2352 x 1568 pixels; 45° field of view: 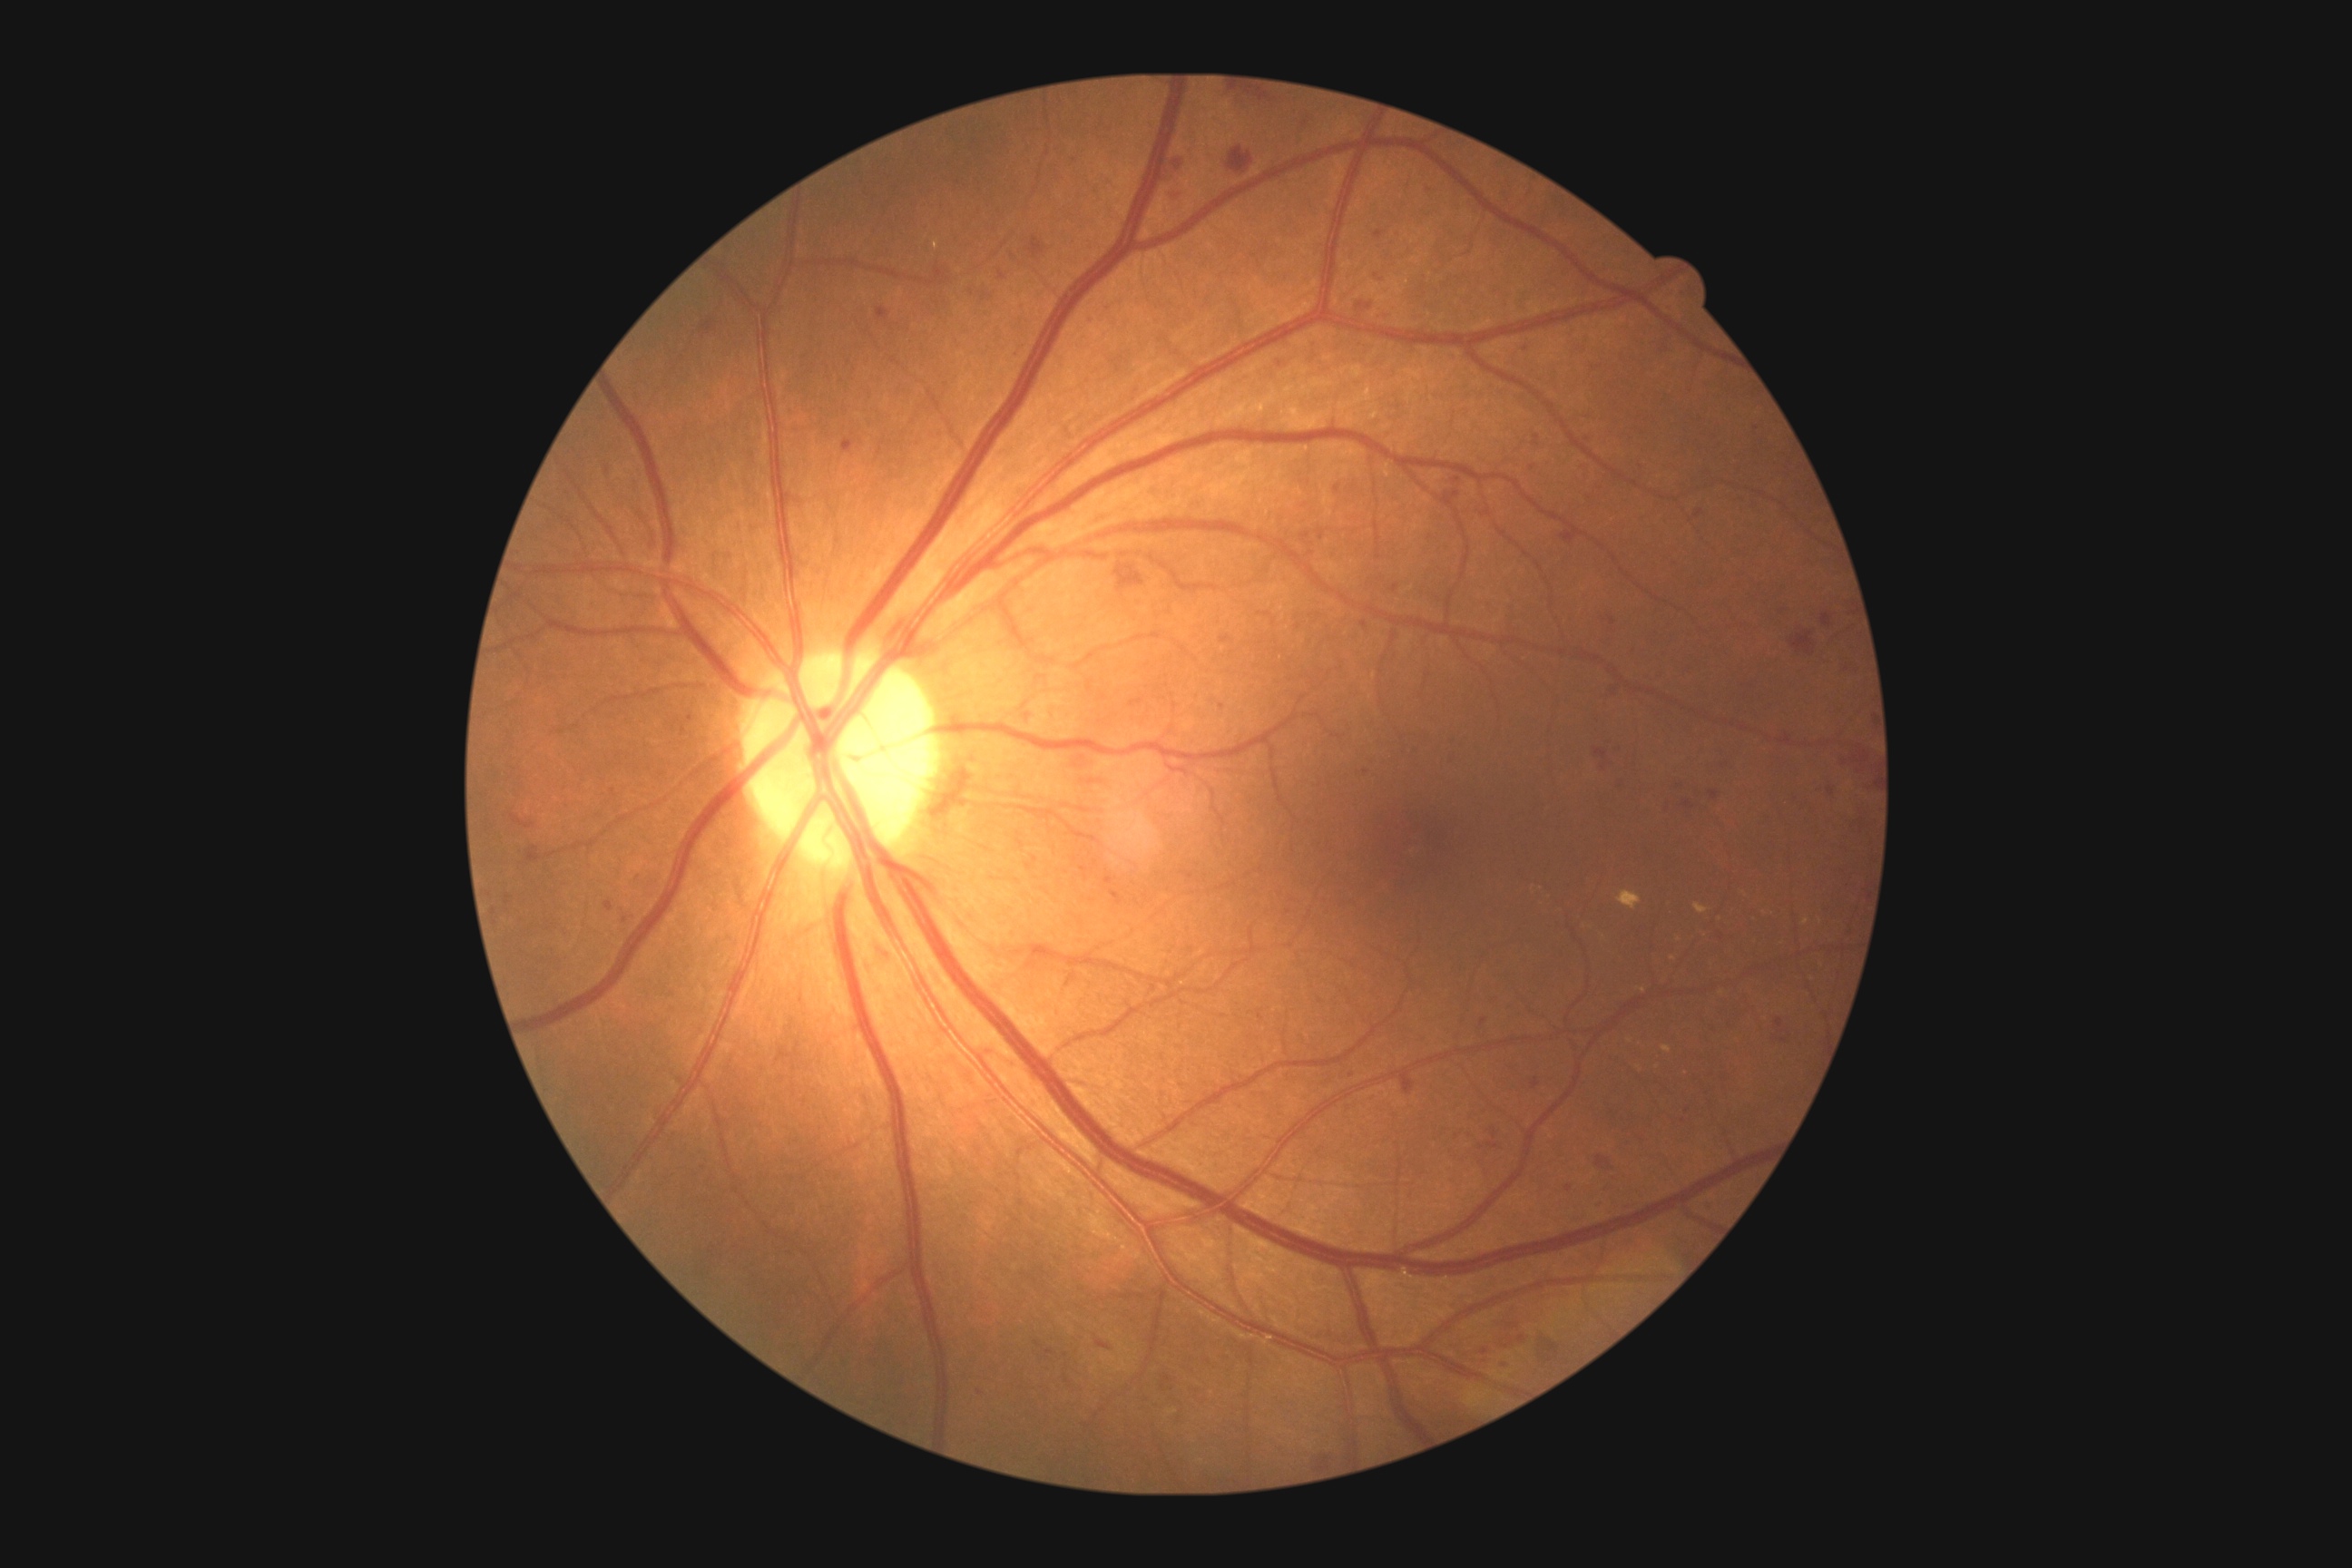

{"partial": true, "dr_grade": 2, "lesions": {"he": [[665, 1004, 678, 1015], [1046, 1349, 1055, 1355], [1028, 237, 1044, 259], [926, 266, 950, 286], [1444, 750, 1458, 765], [1612, 745, 1627, 752], [1779, 734, 1792, 747], [1113, 564, 1146, 593], [1776, 1019, 1783, 1028], [1790, 632, 1816, 658], [1110, 890, 1124, 906], [1220, 636, 1230, 645], [1709, 790, 1720, 801], [605, 903, 612, 912], [607, 467, 611, 475]], "he_small_centers": [[1784, 1041], [1095, 864], [1482, 1148], [623, 907]]}}